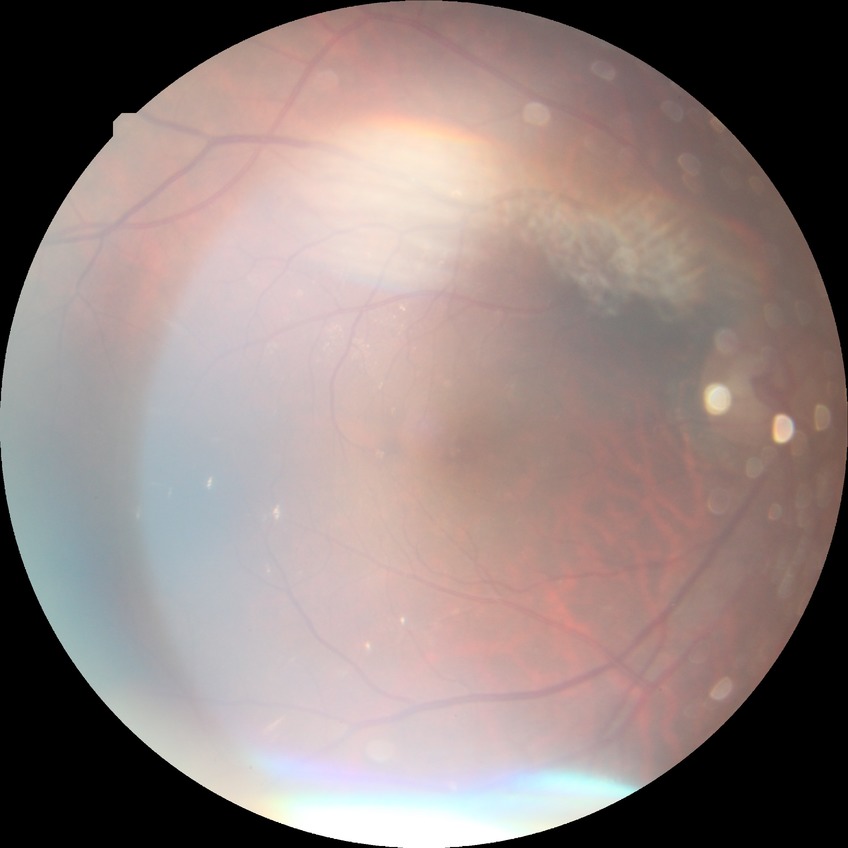

{
  "davis_grade": "SDR"
}